45° field of view: 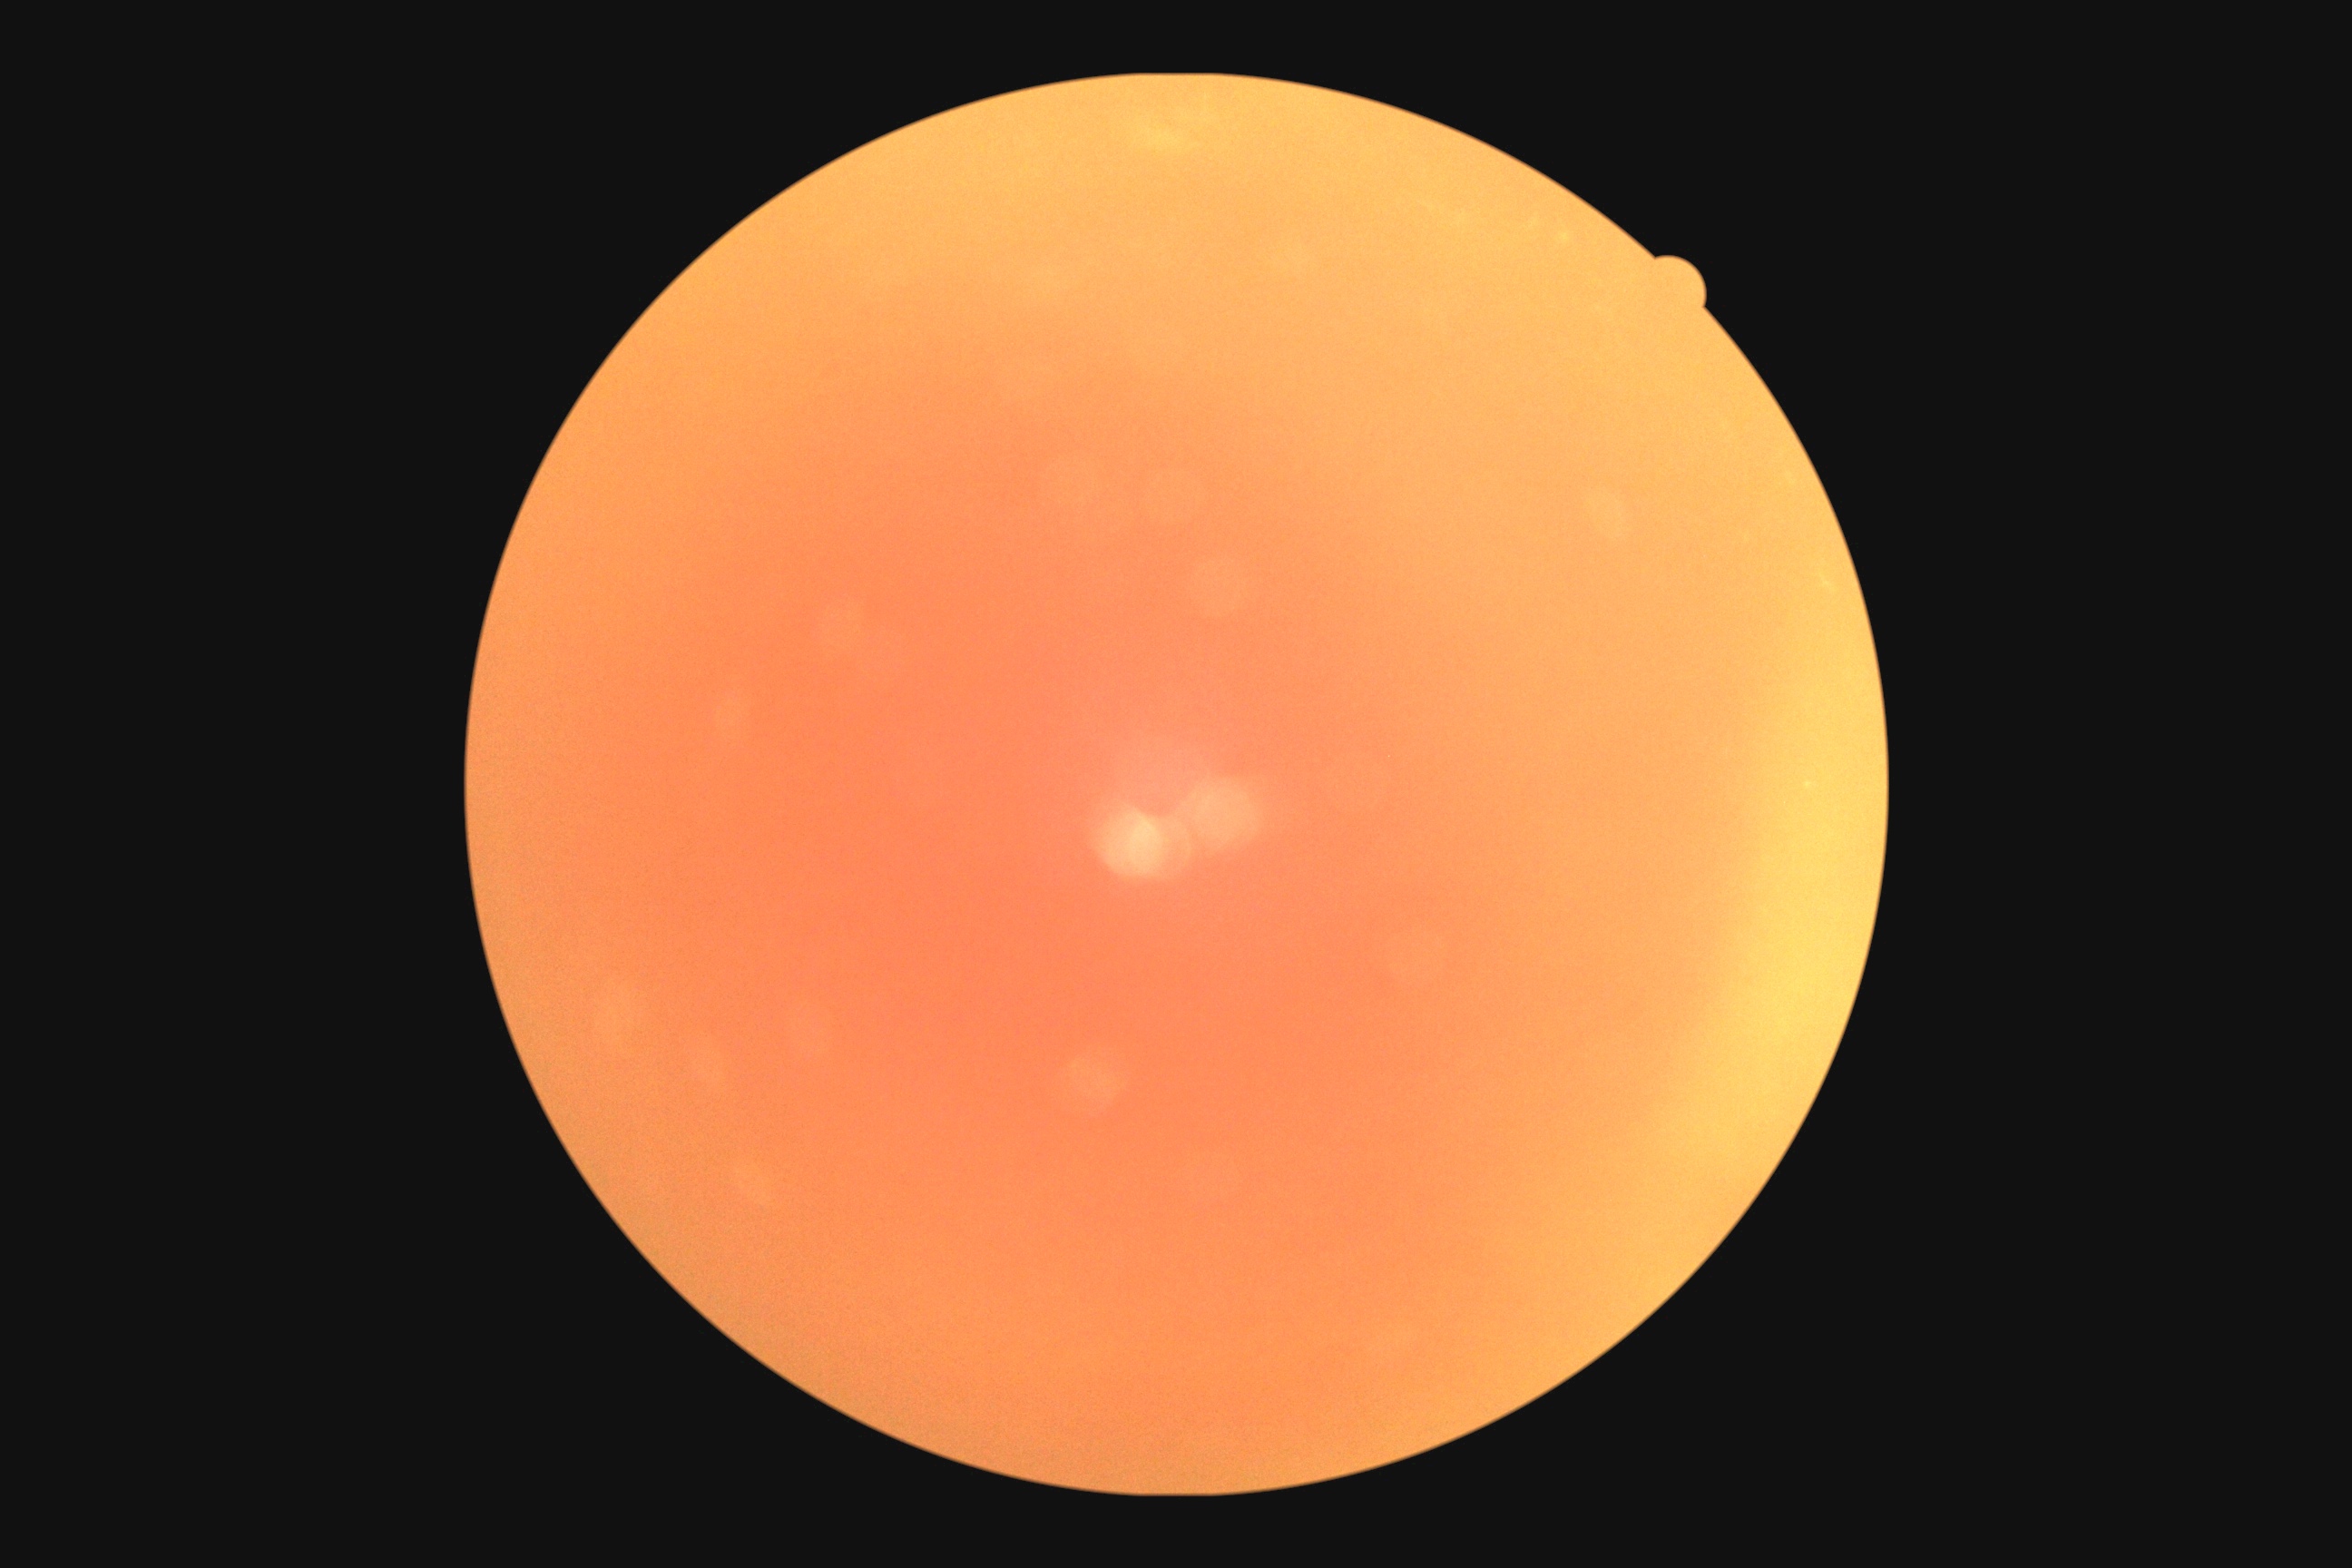

Findings:
• retinopathy: ungradable due to poor image quality
• image quality: insufficient for DR assessment